Phoenix ICON, 100° FOV. Phoenix ICON wide-field infant fundus image. 1240 by 1240 pixels: 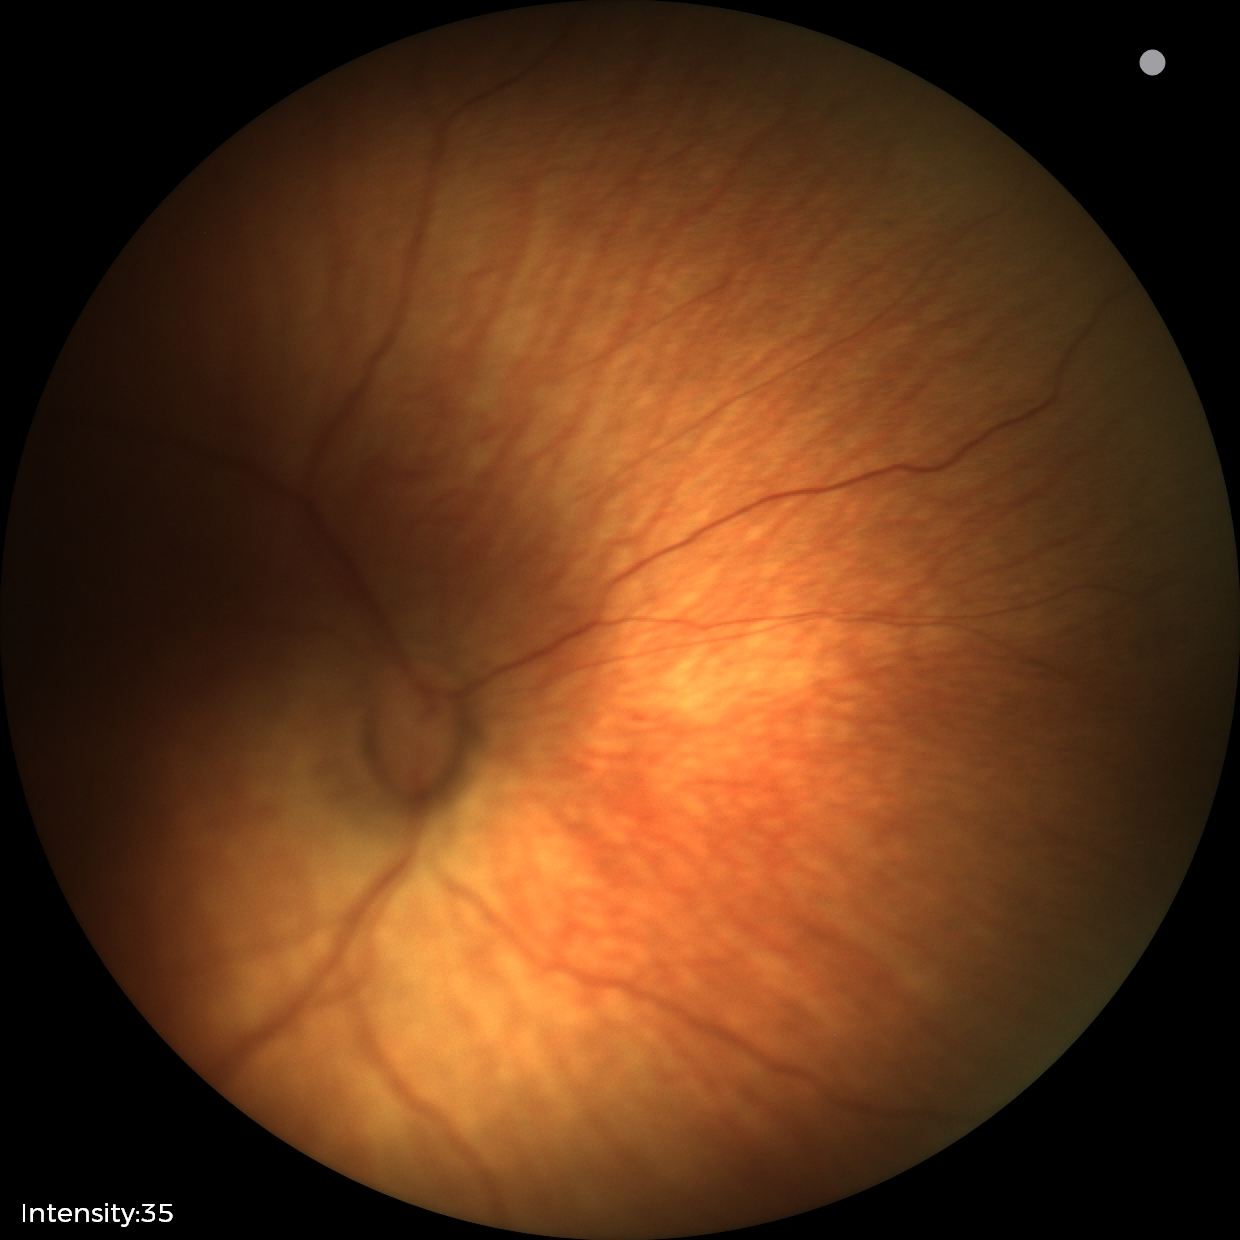 No plus disease. Screening examination consistent with status post ROP.